Acquired with a NIDEK AFC-230 · graded on the modified Davis scale.
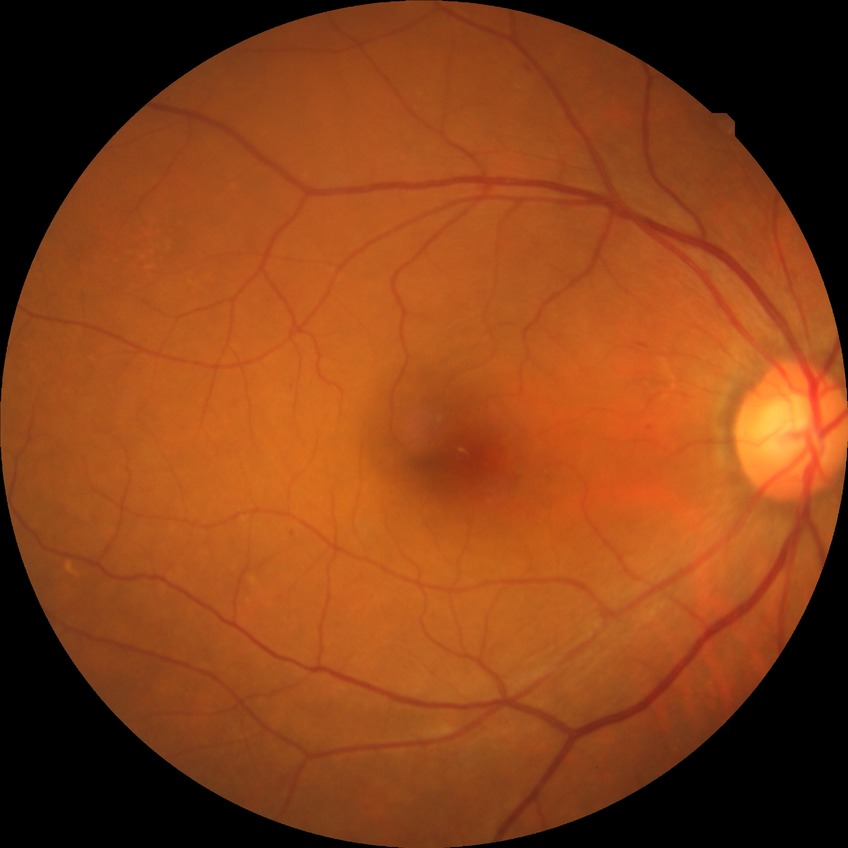 Retinopathy grade: simple diabetic retinopathy.